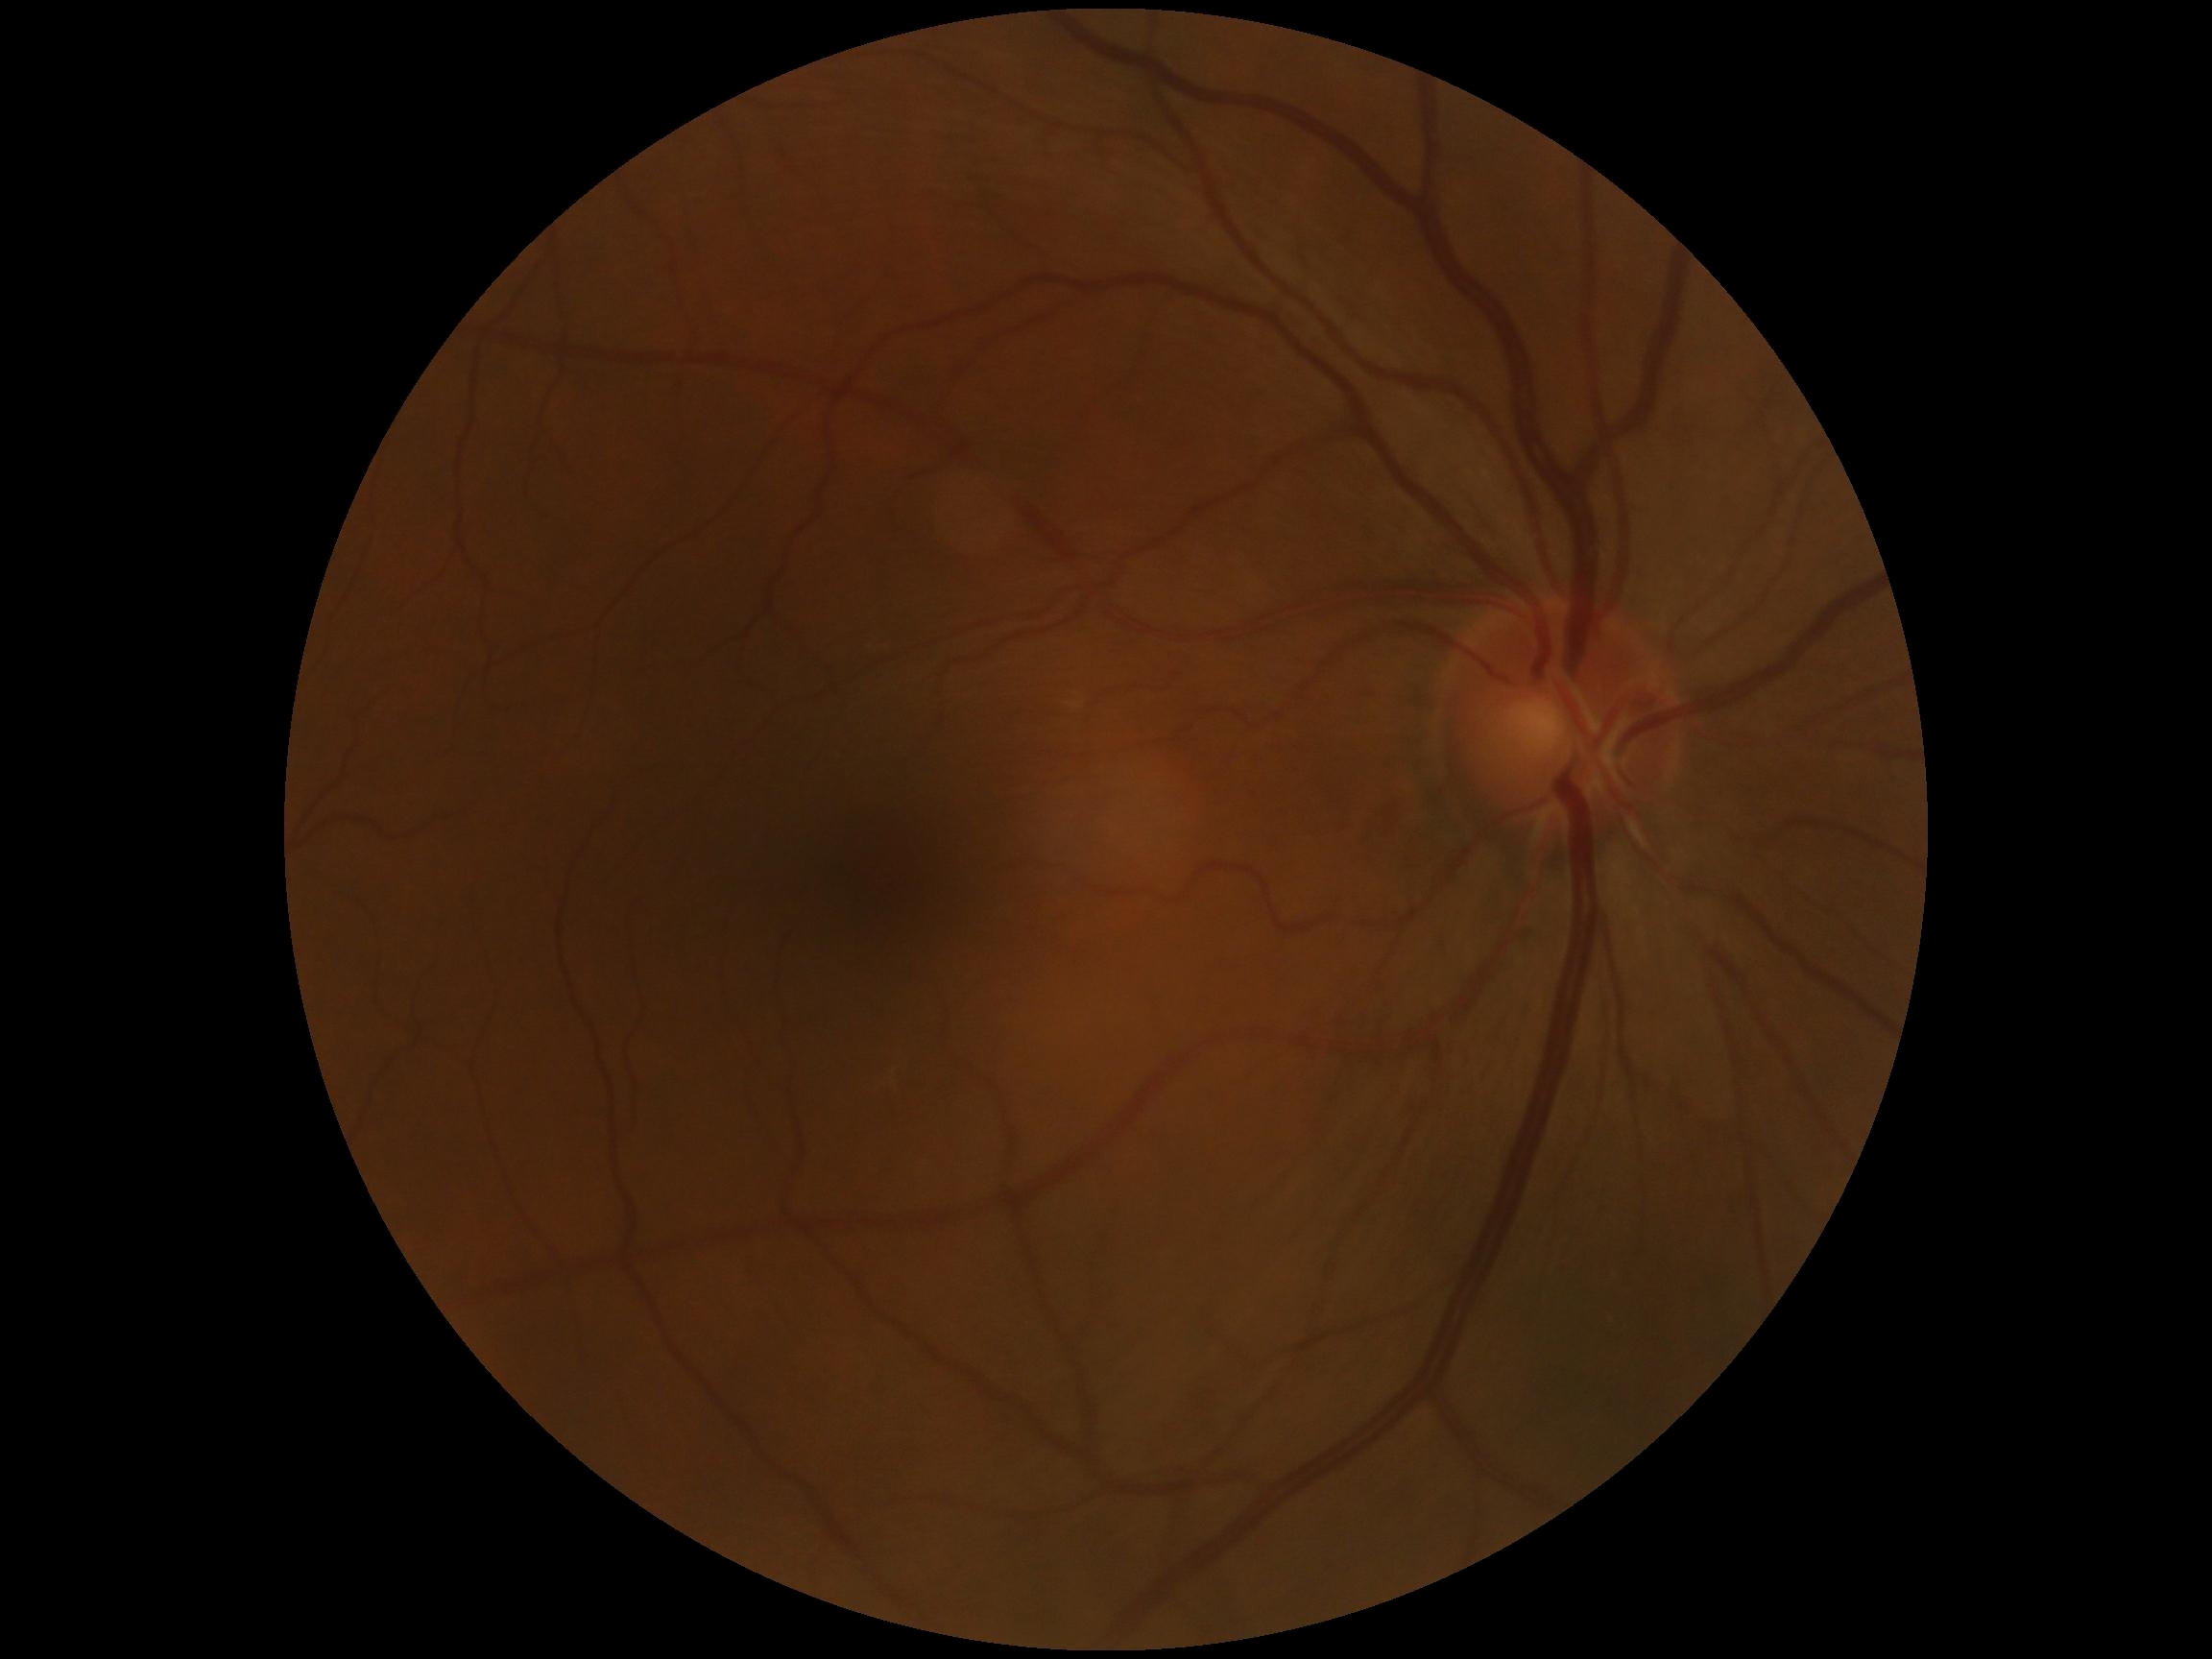

DR impression = no apparent DR | DR grade = 0.